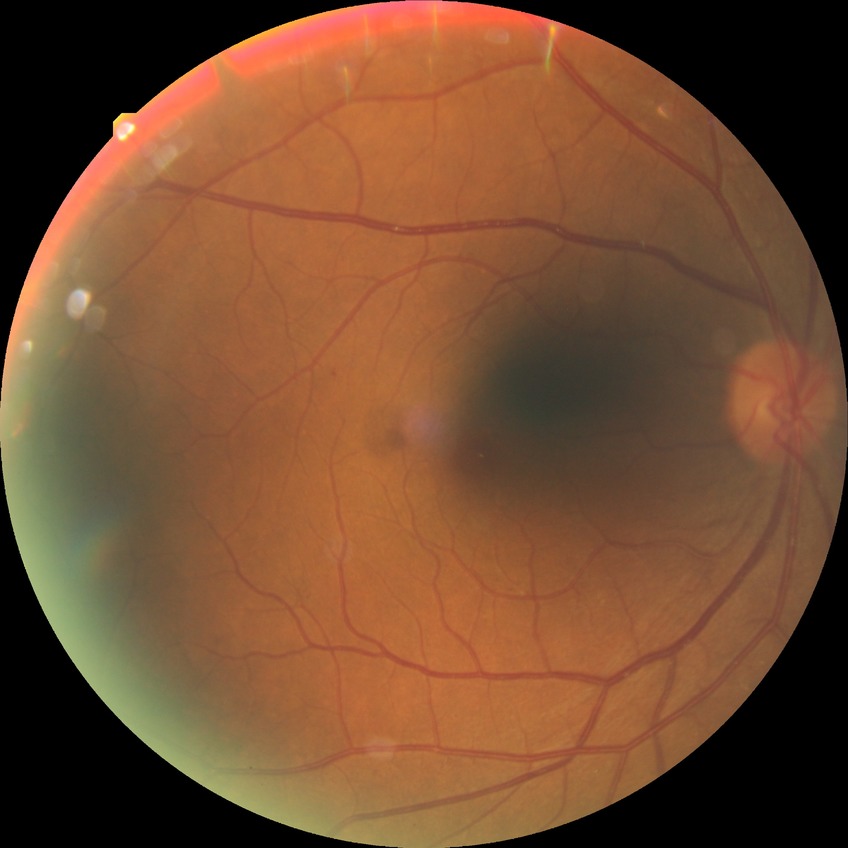
diabetic retinopathy stage: simple diabetic retinopathy.